Davis DR grading, 45° field of view, CFP.
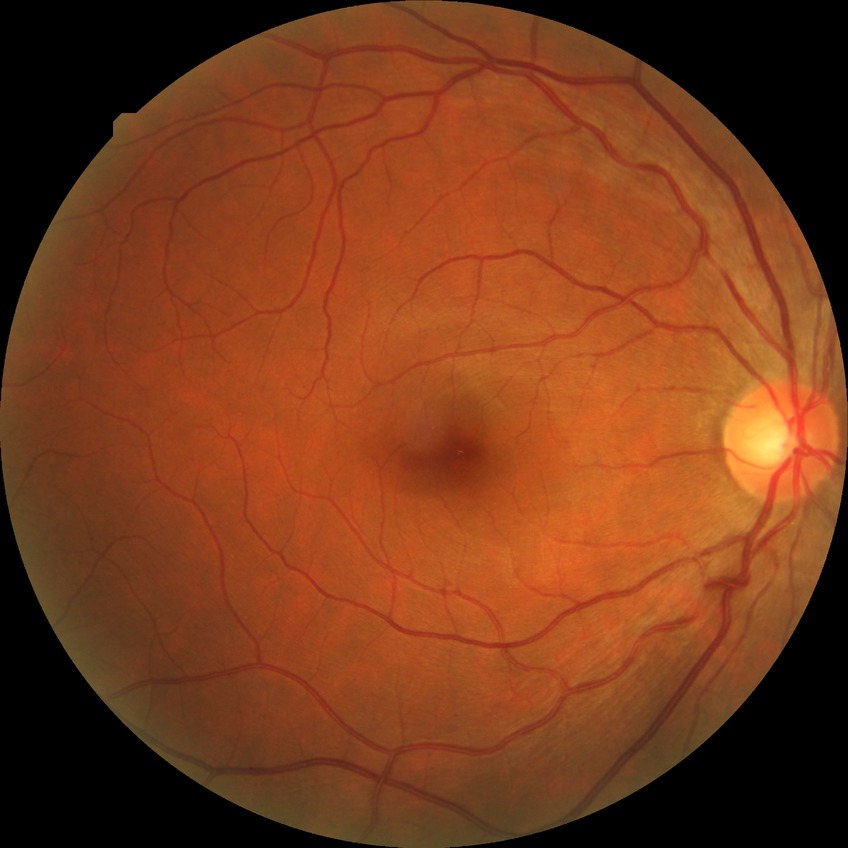 Diabetic retinopathy (DR): NDR (no diabetic retinopathy).